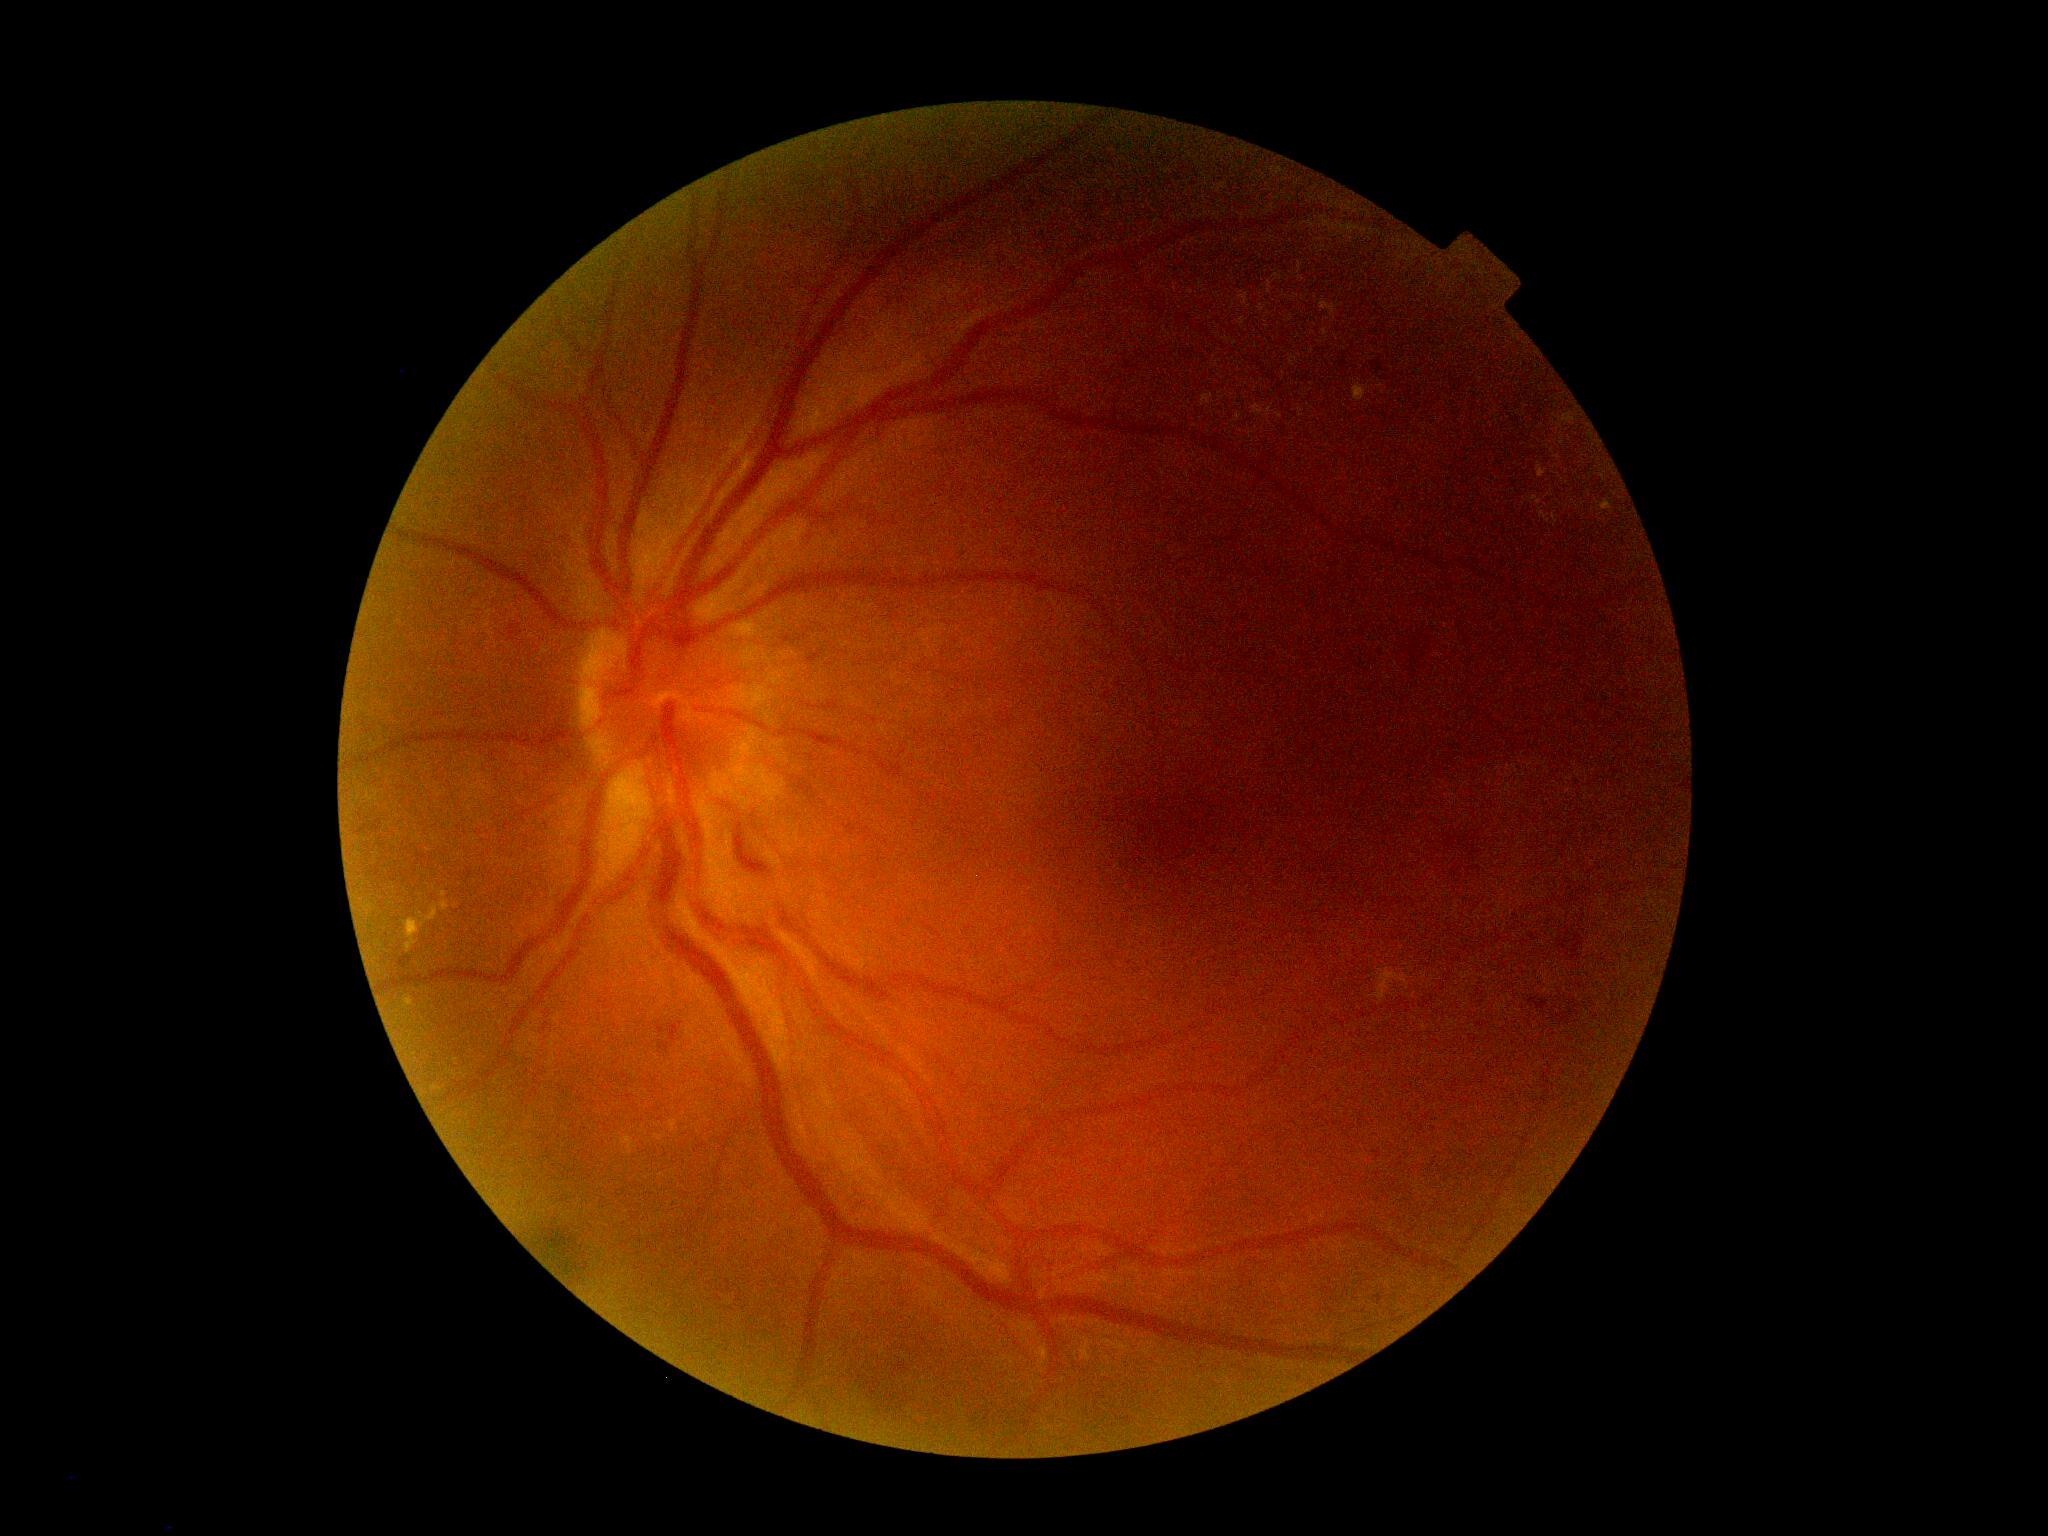
Findings:
• DR — 2/4